Color fundus photograph:
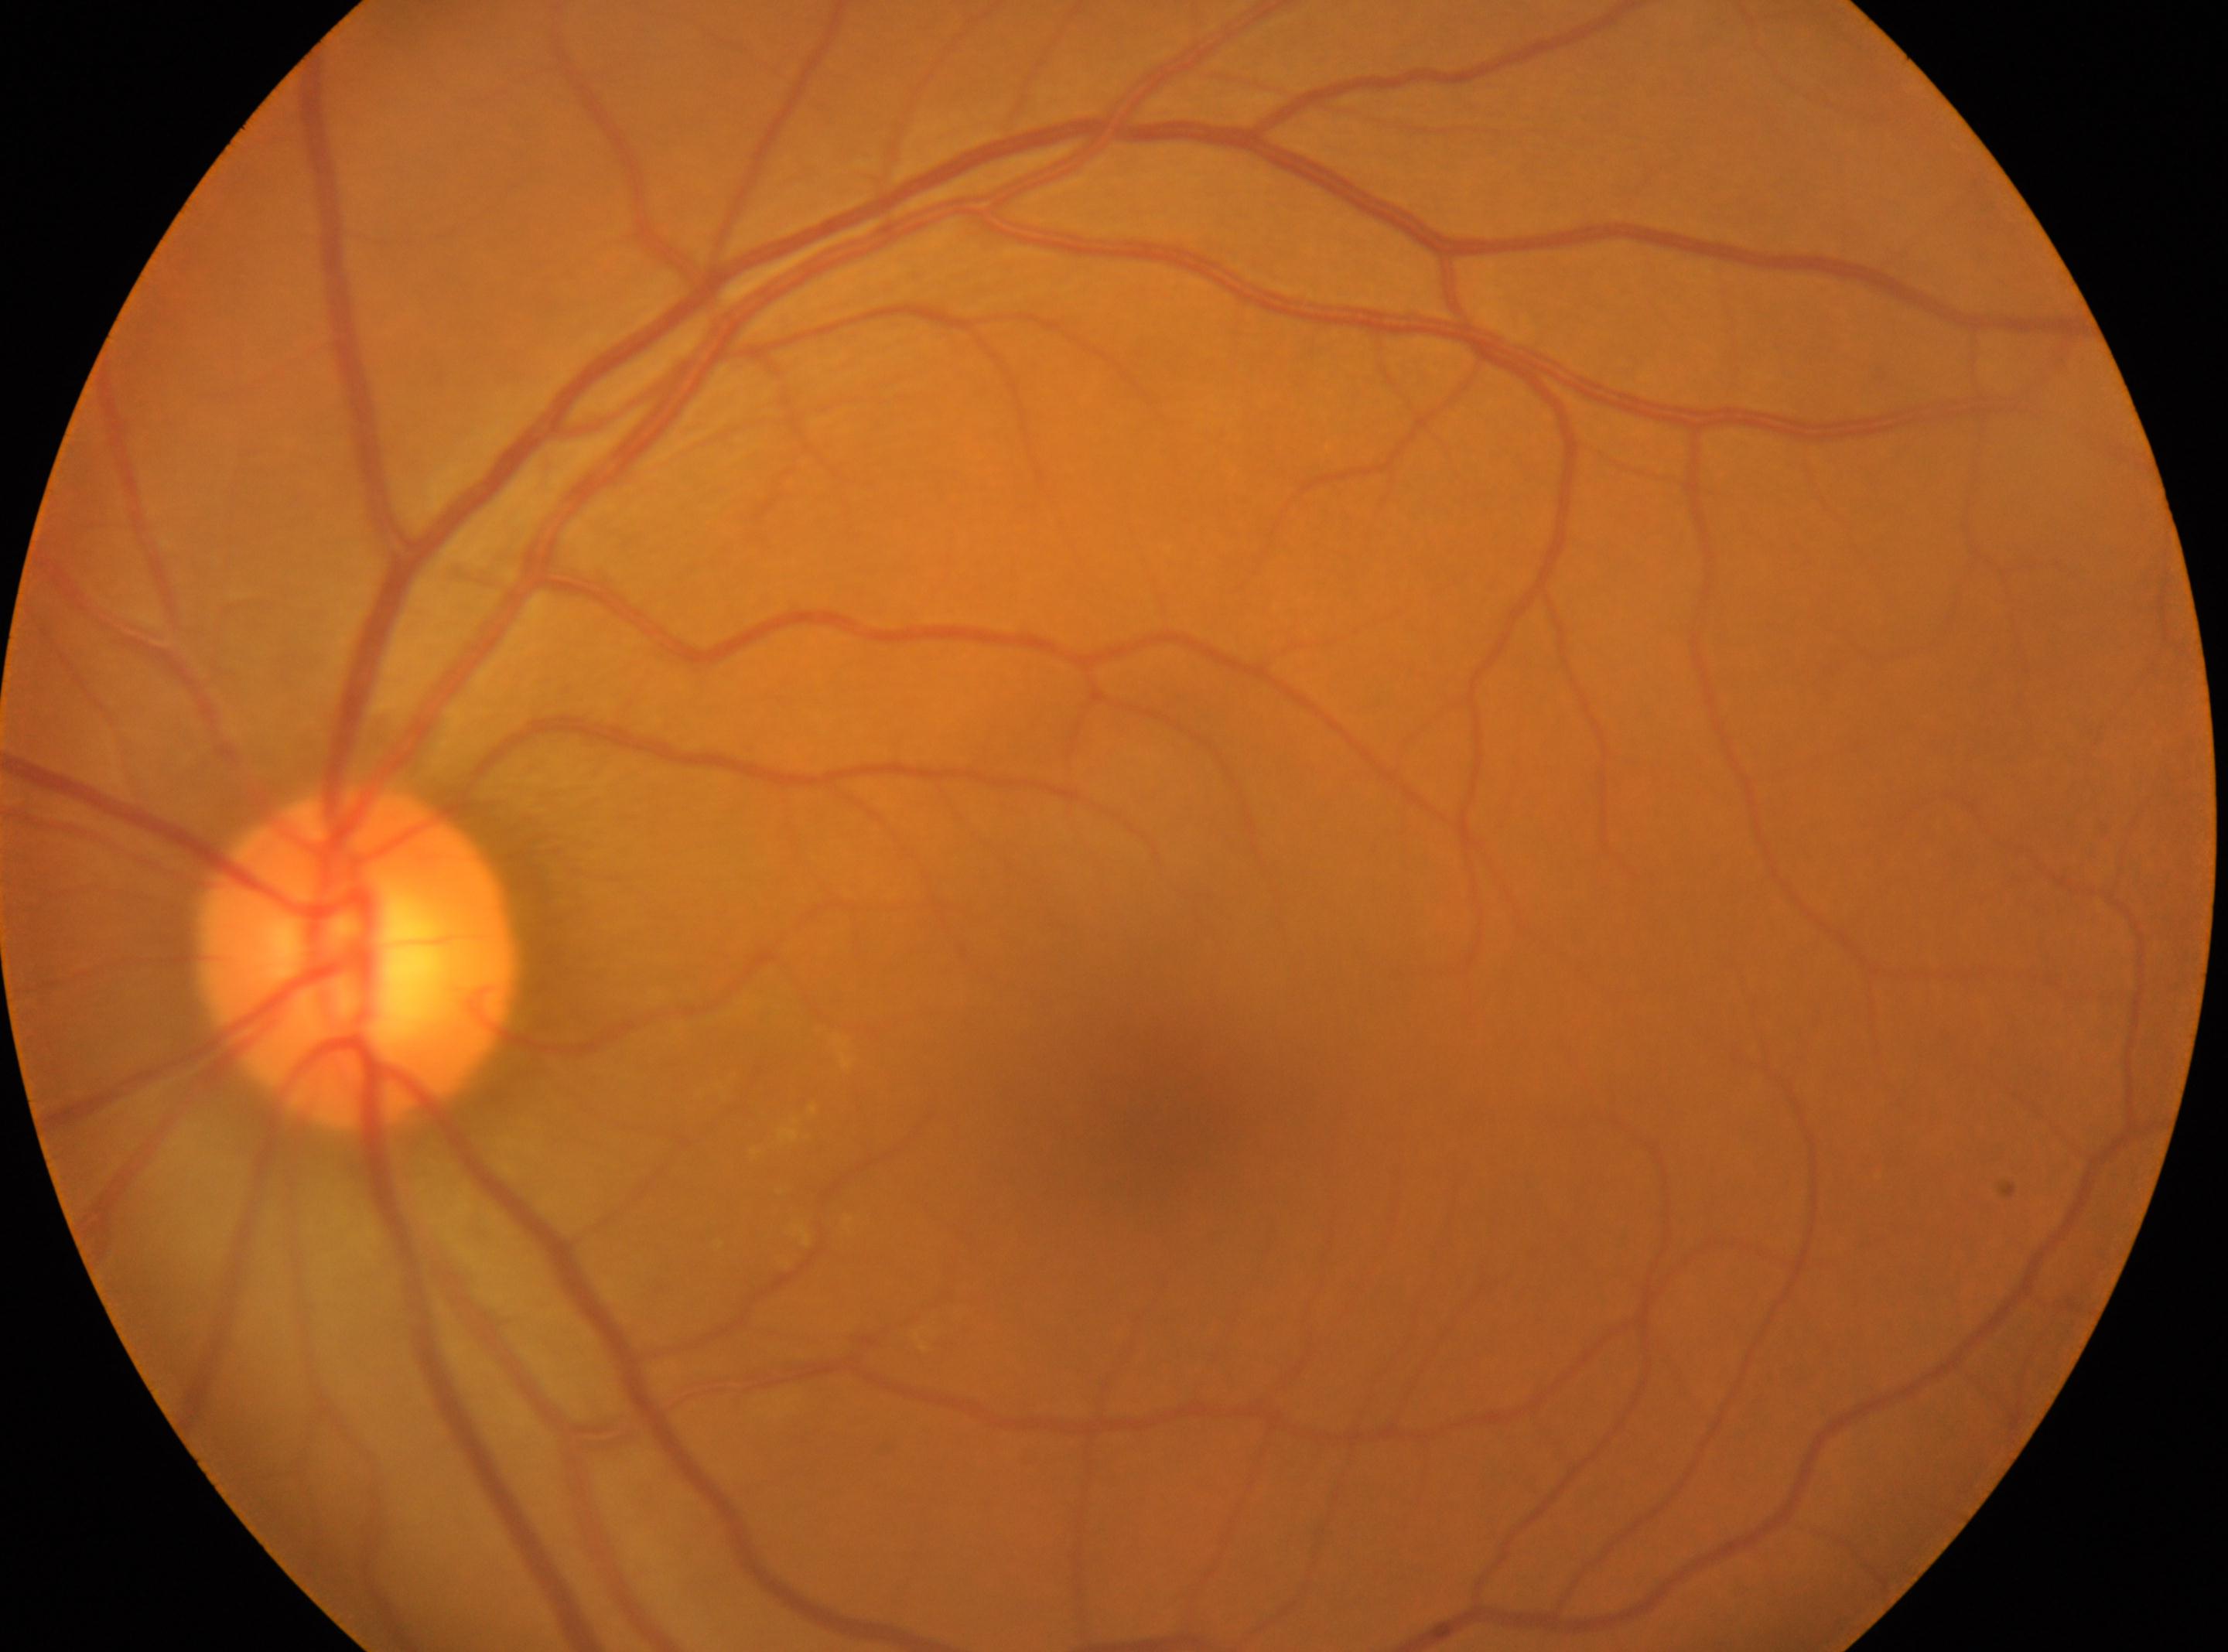 Disc center: (x=356, y=960).
Imaged eye: left eye.
The fovea is at (x=1154, y=1134).
DR severity: no apparent retinopathy (grade 0).